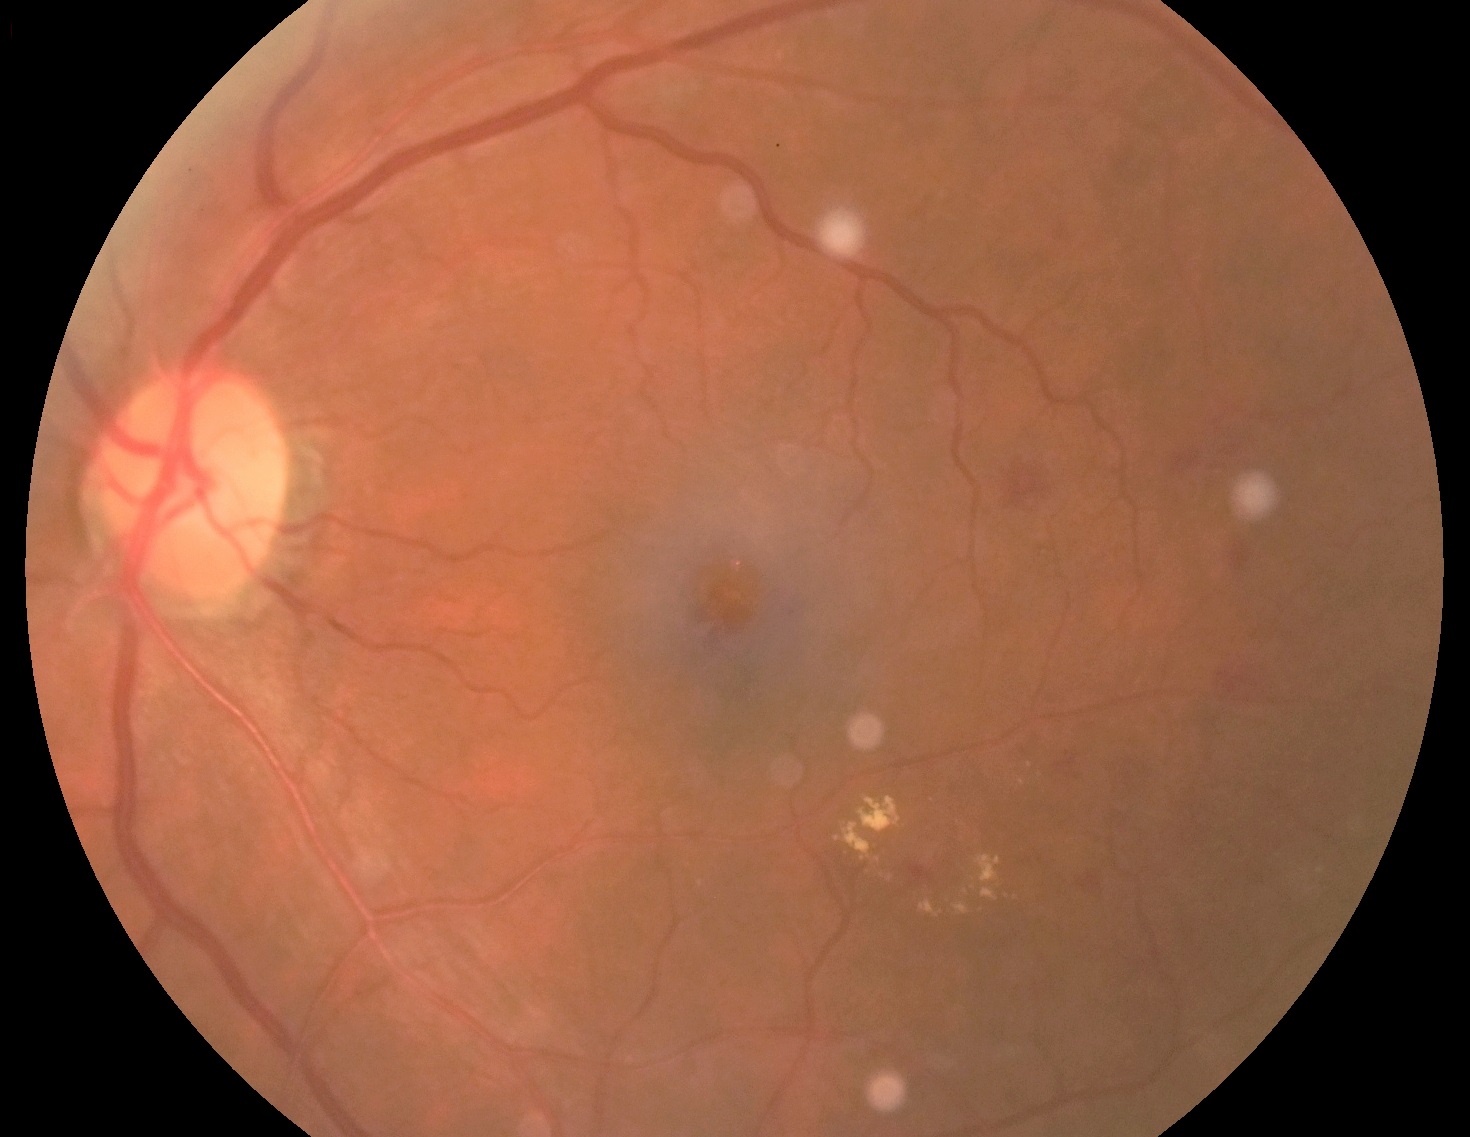
Annotations:
* DR stage: grade 2
* DR class: non-proliferative diabetic retinopathy